No pharmacologic dilation:
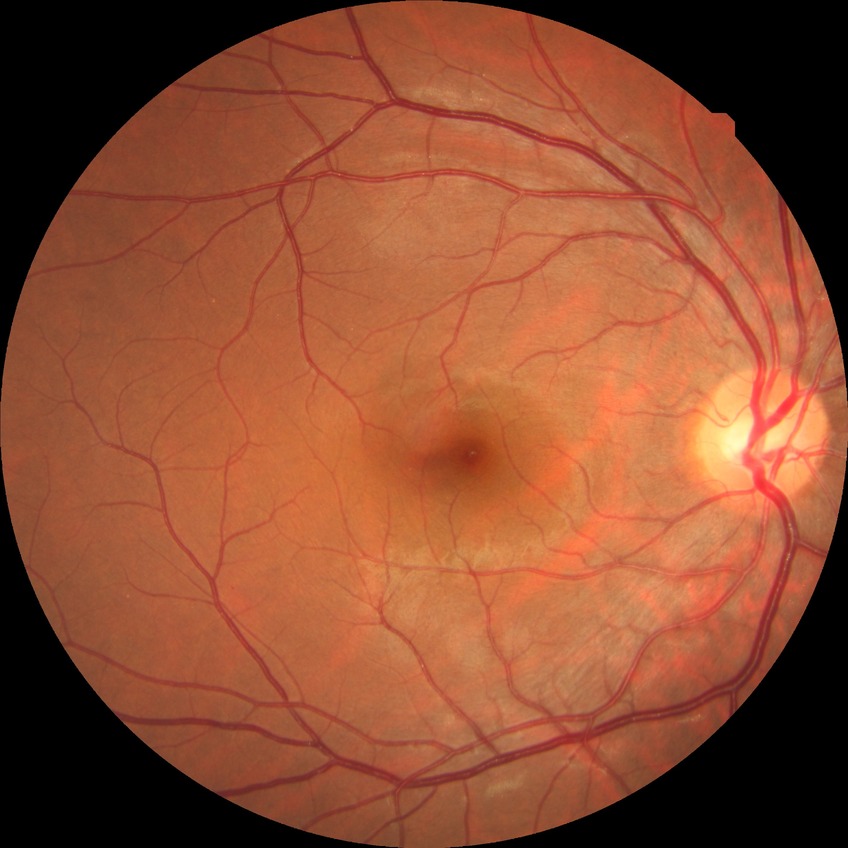 modified Davis classification: simple diabetic retinopathy